Pediatric wide-field fundus photograph.
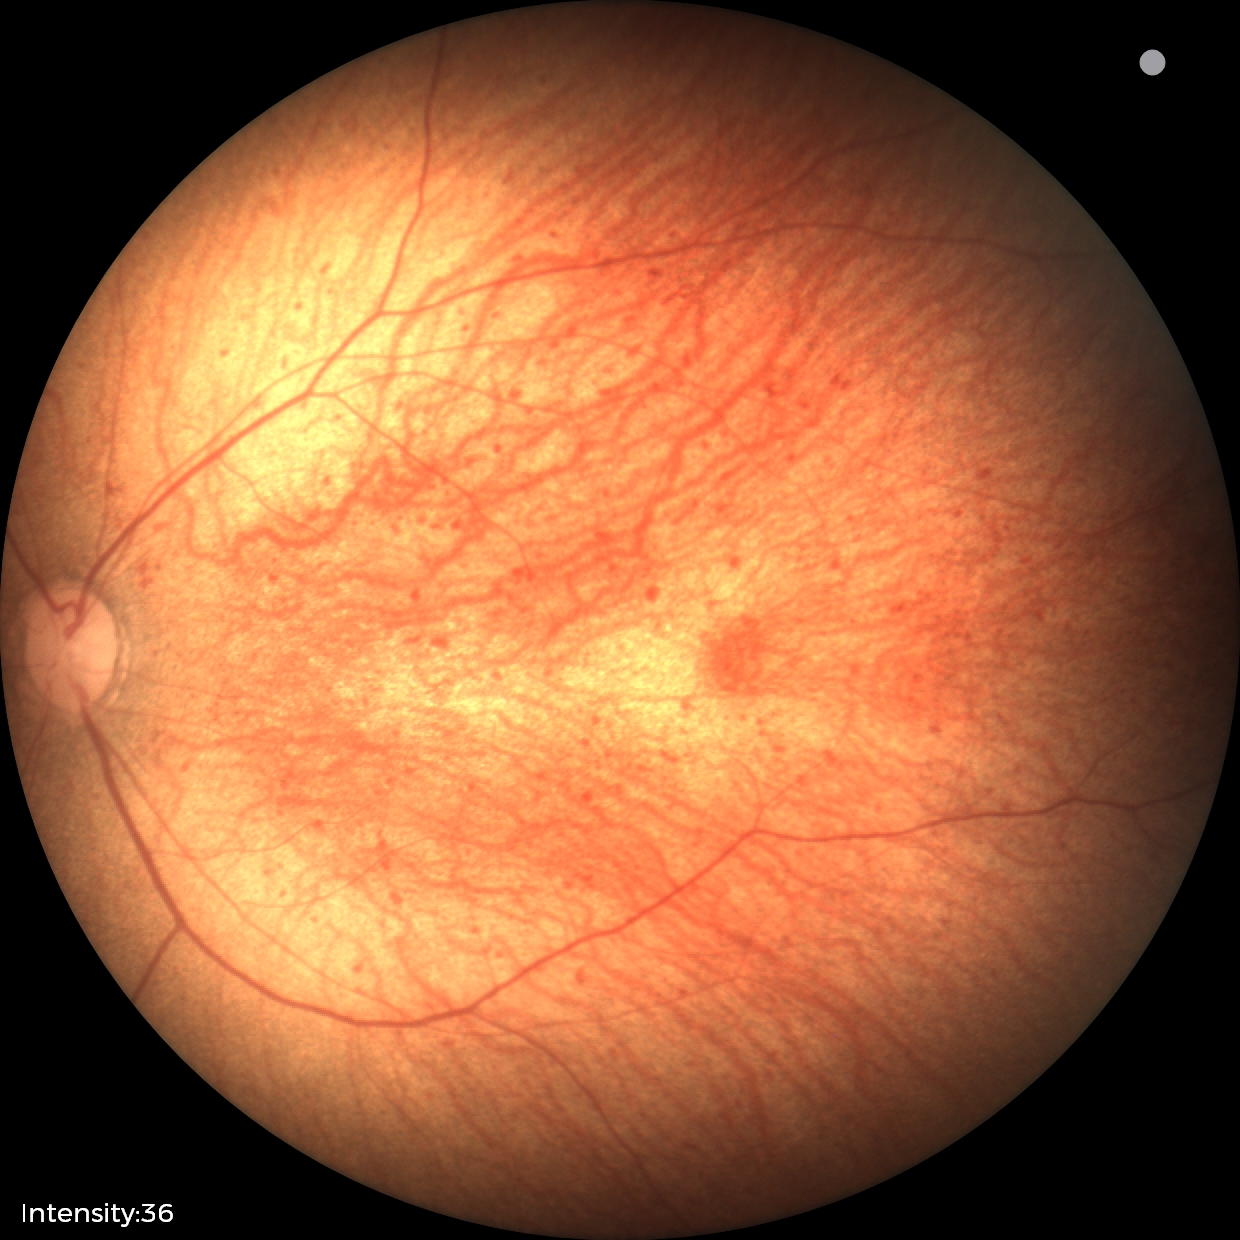 No retinal pathology identified on screening.